Wide-field fundus photograph of an infant · captured with the Phoenix ICON (100° field of view) · 1240x1240px — 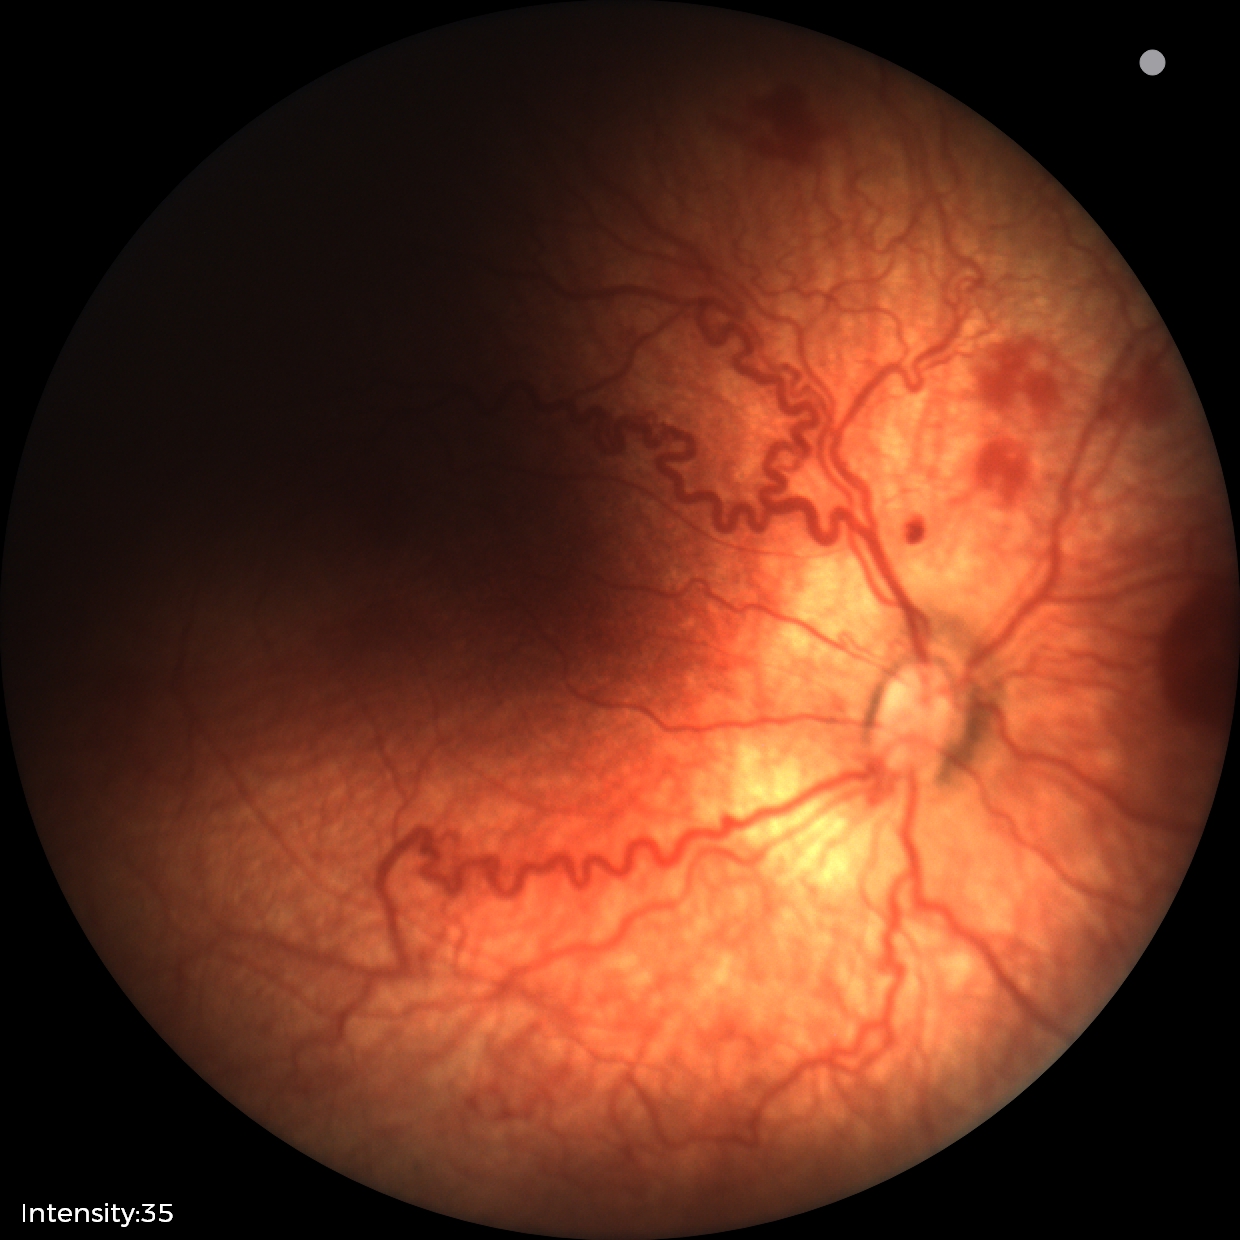

Plus disease present.
Examination diagnosed as retinopathy of prematurity (ROP) stage 2.